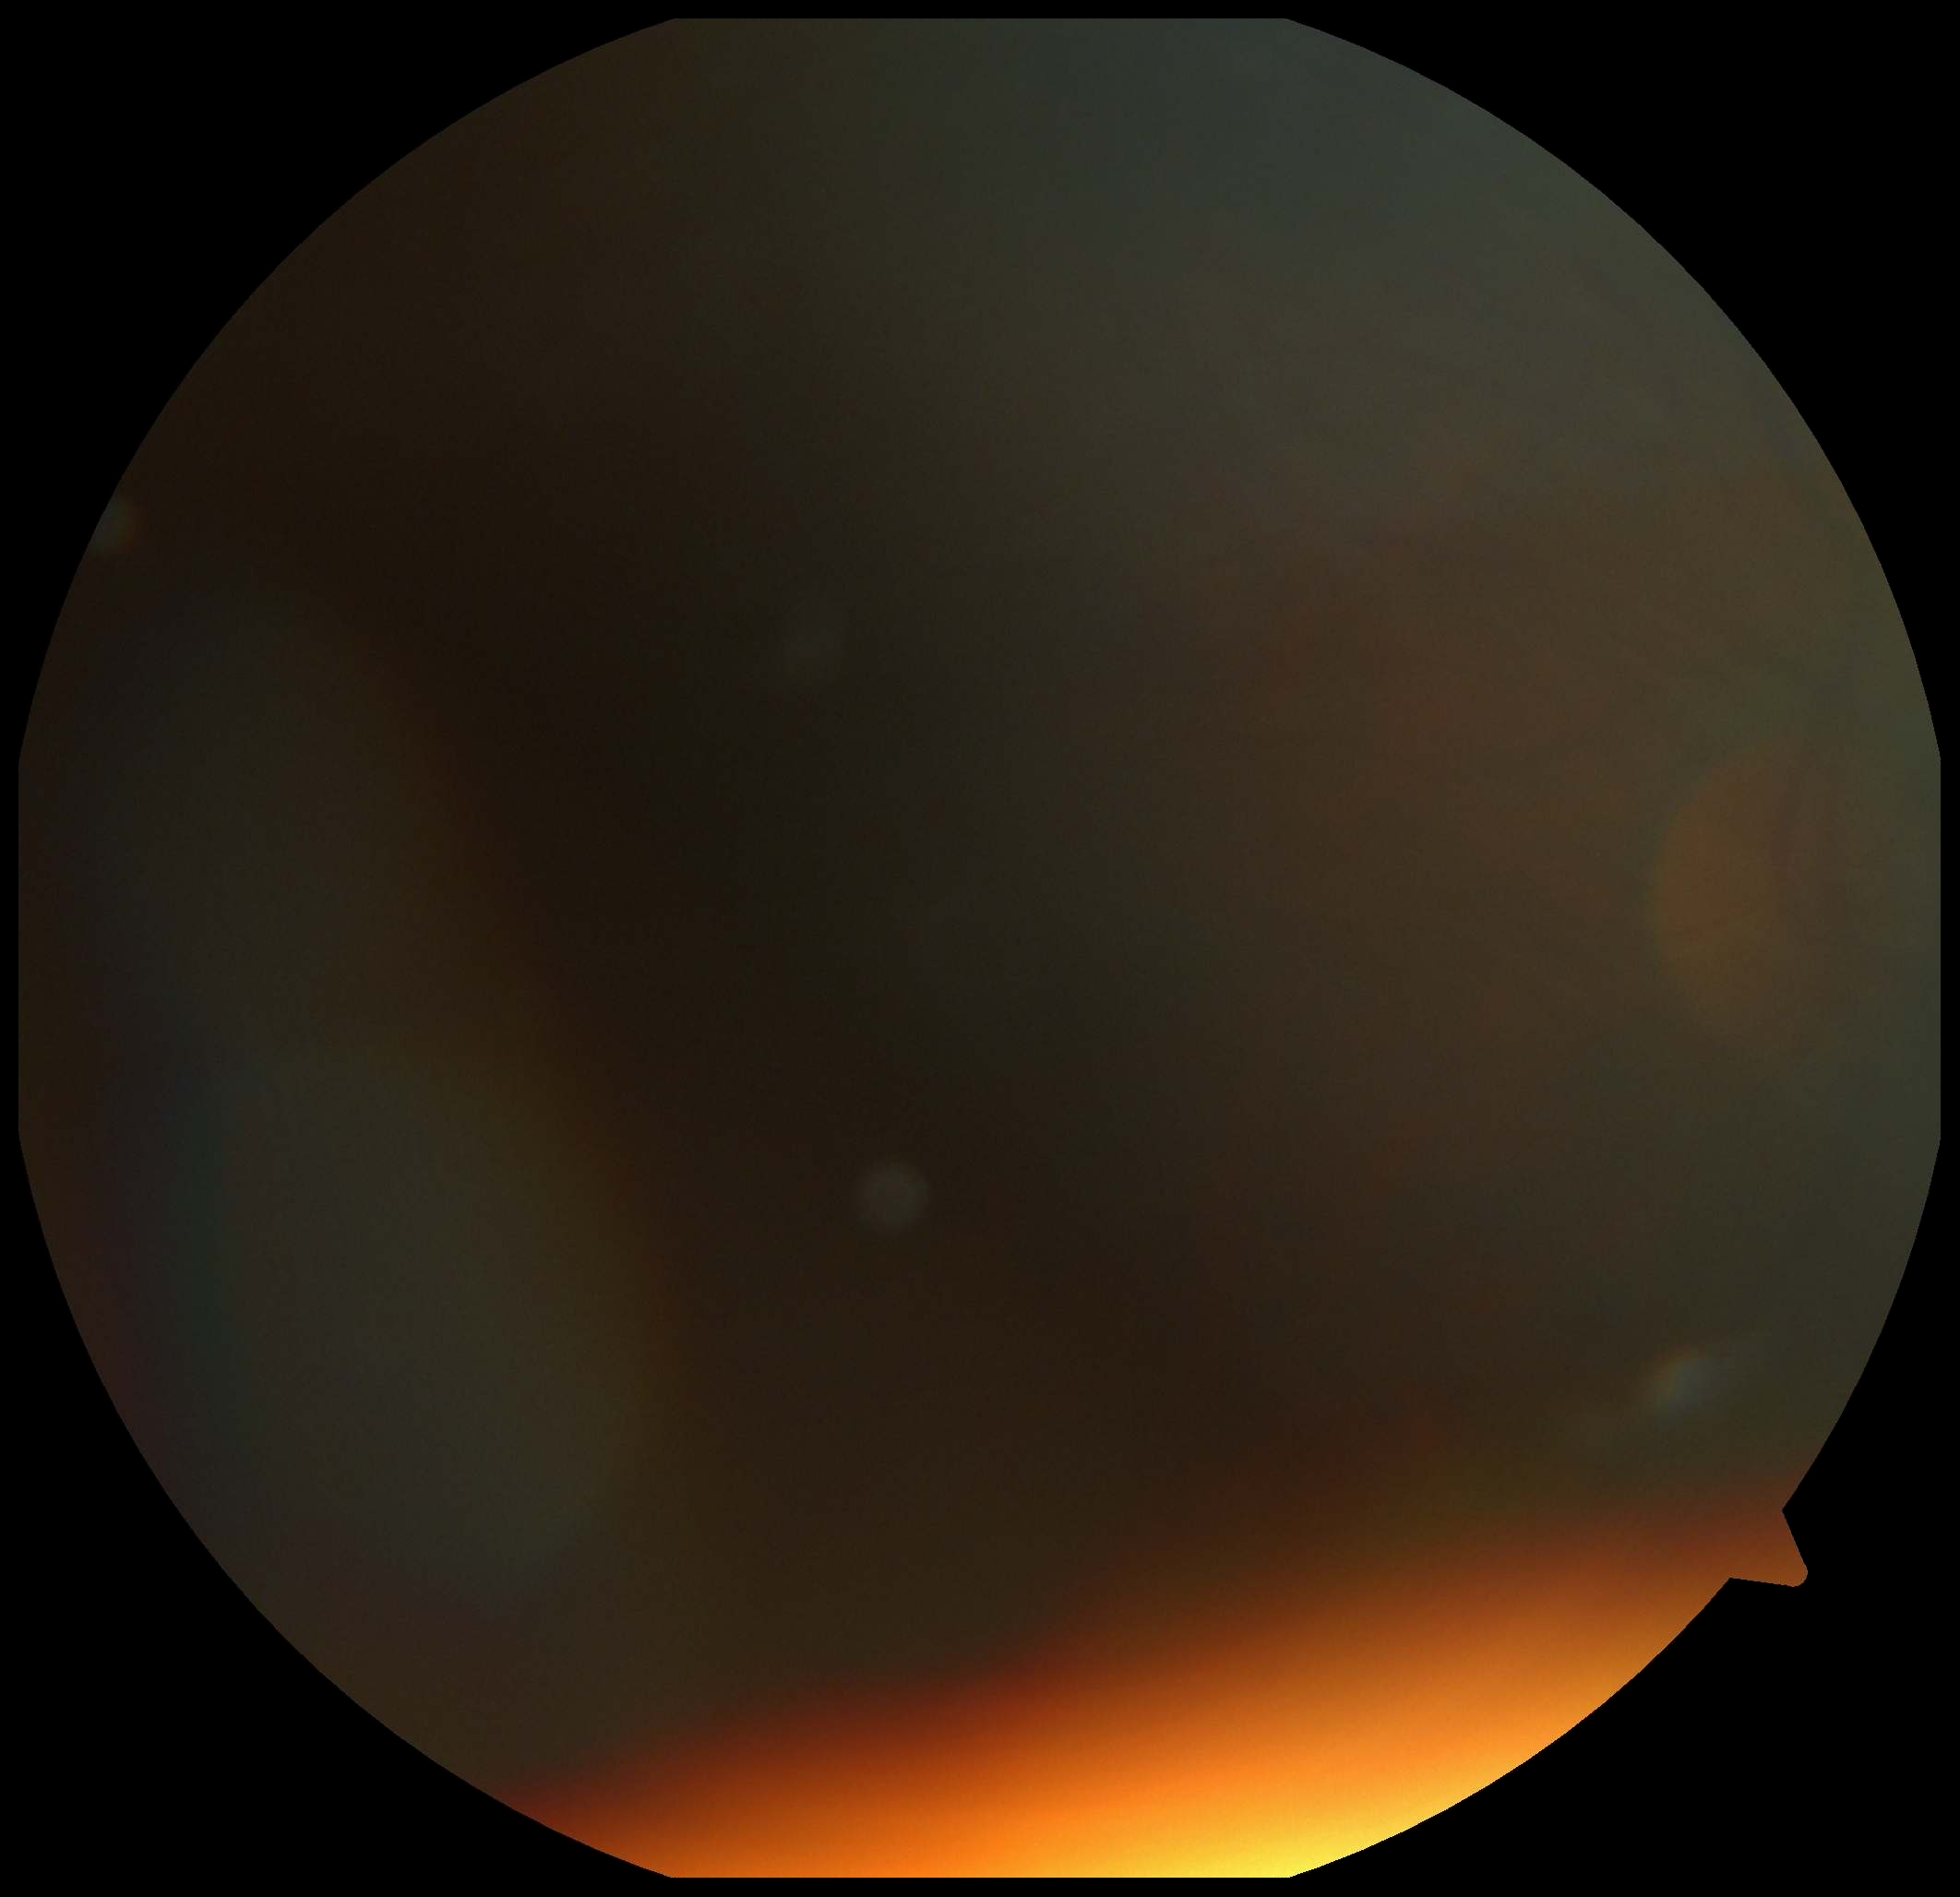

Diabetic retinopathy (DR) is ungradable due to poor image quality. Ungradable image — DR severity cannot be determined.